Infant wide-field fundus photograph; captured with the Phoenix ICON (100° field of view)
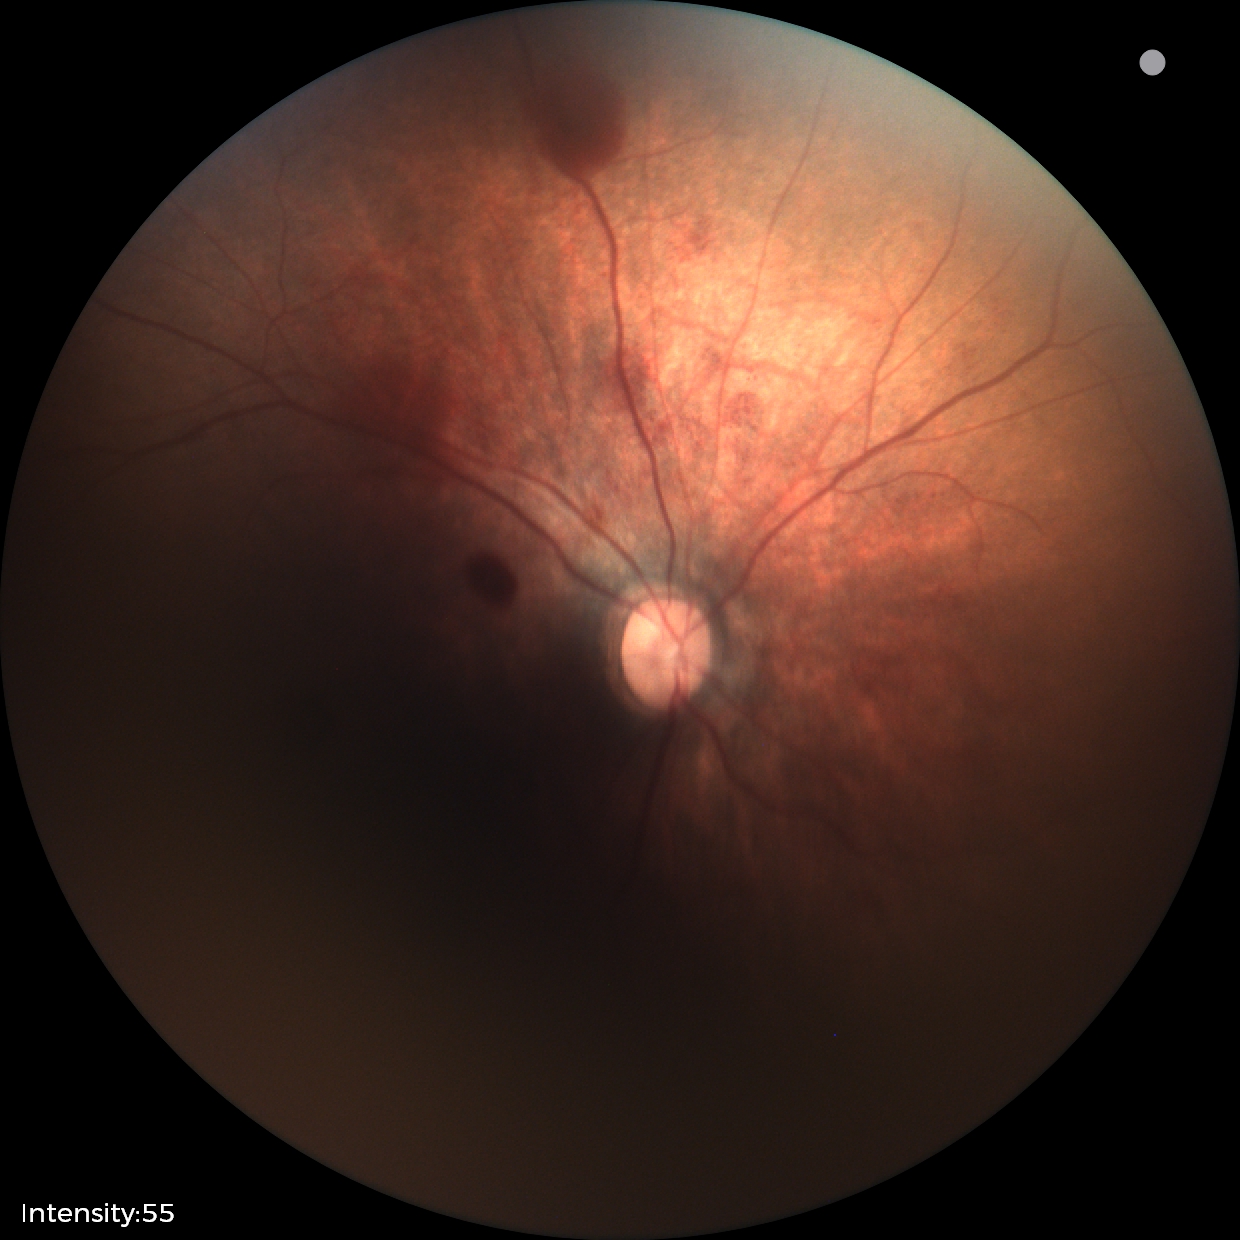 Screening examination consistent with retinal hemorrhages.